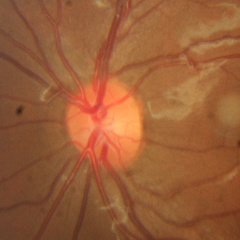 Assessment = no glaucomatous findings.